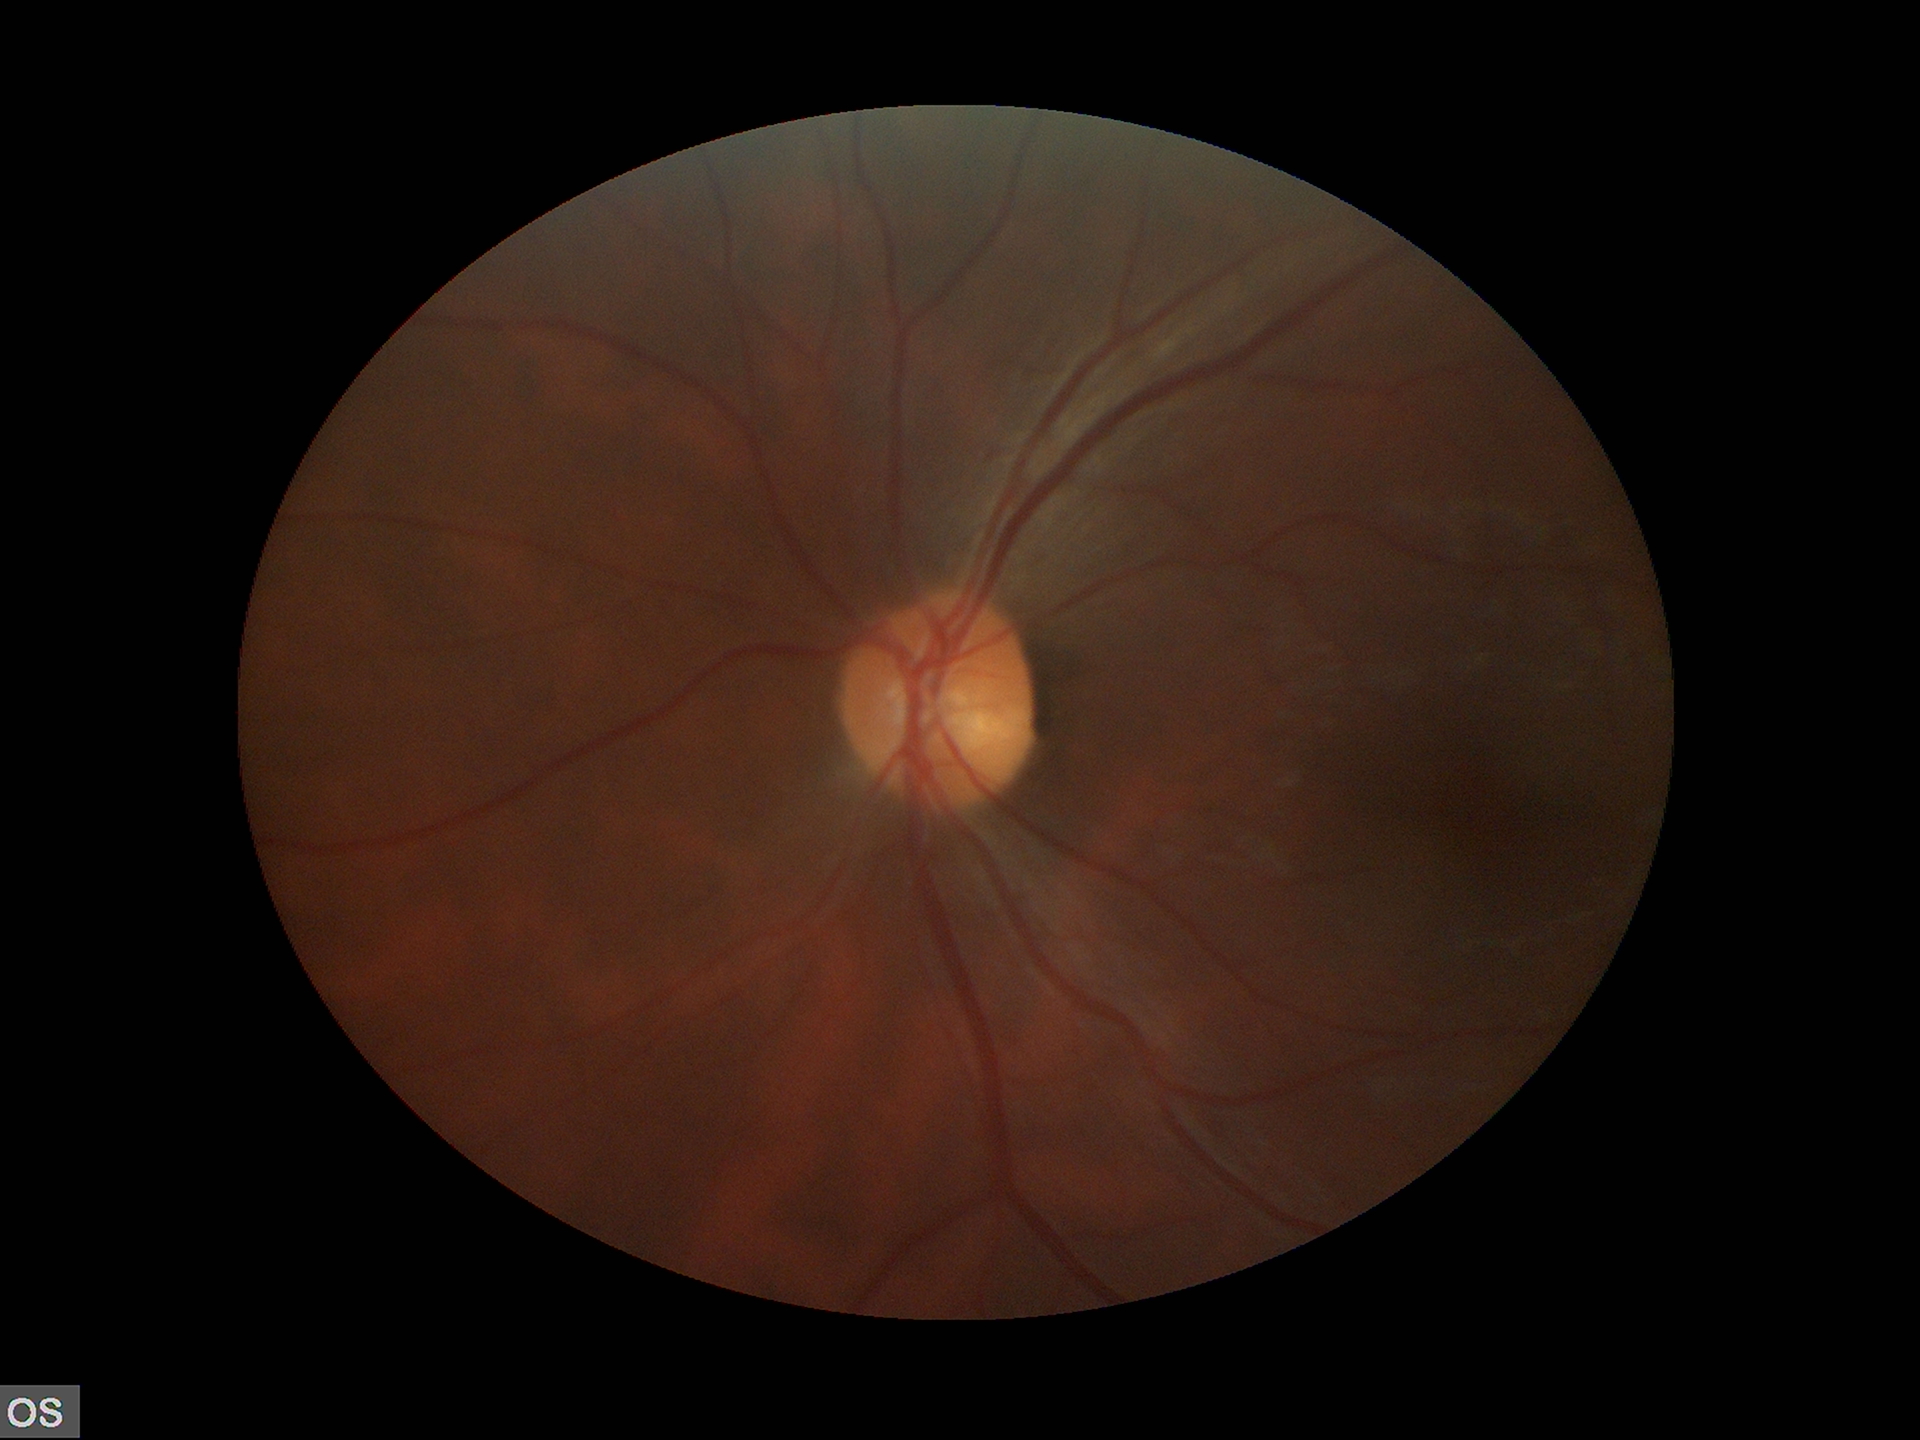 Glaucoma decision=negative | vertical cup-to-disc ratio (VCDR)=0.47